1659x2212px
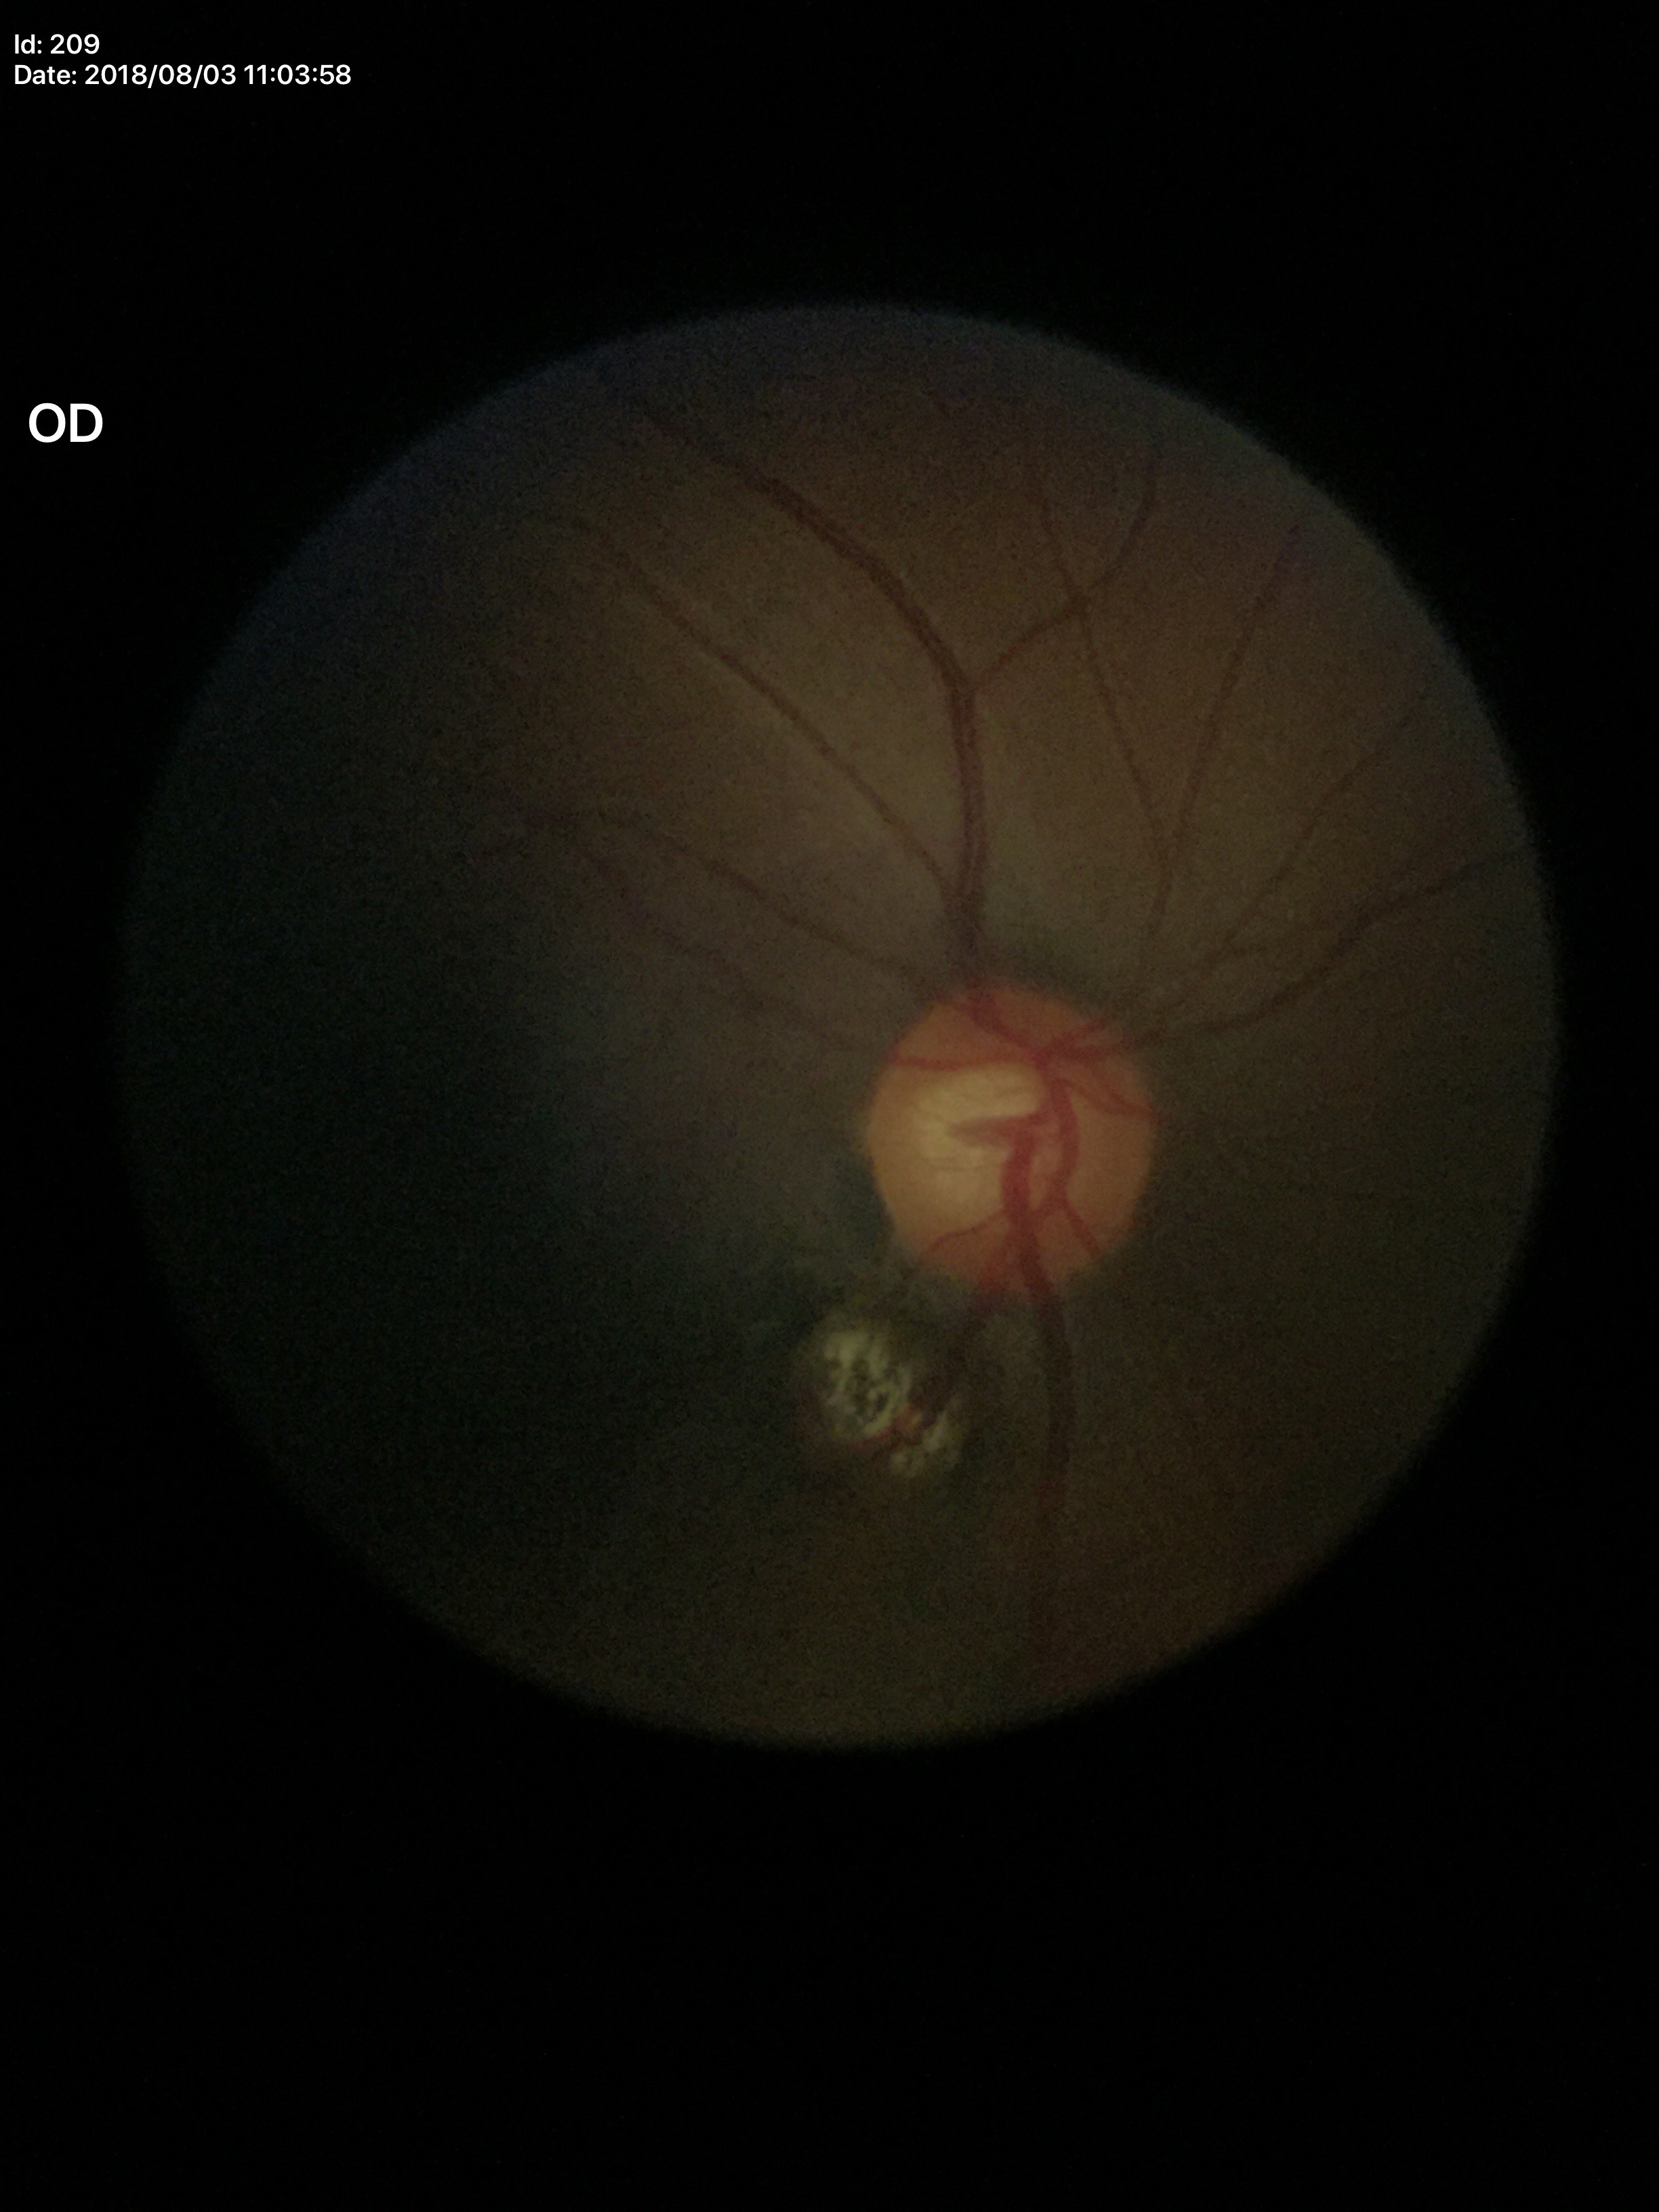

Optic disc analysis:
- Glaucoma assessment: not suspect (2 of 5 graders flagged glaucoma suspect)
- vertical cup-to-disc ratio (VCDR): 0.58